CFP. 1932x1916: 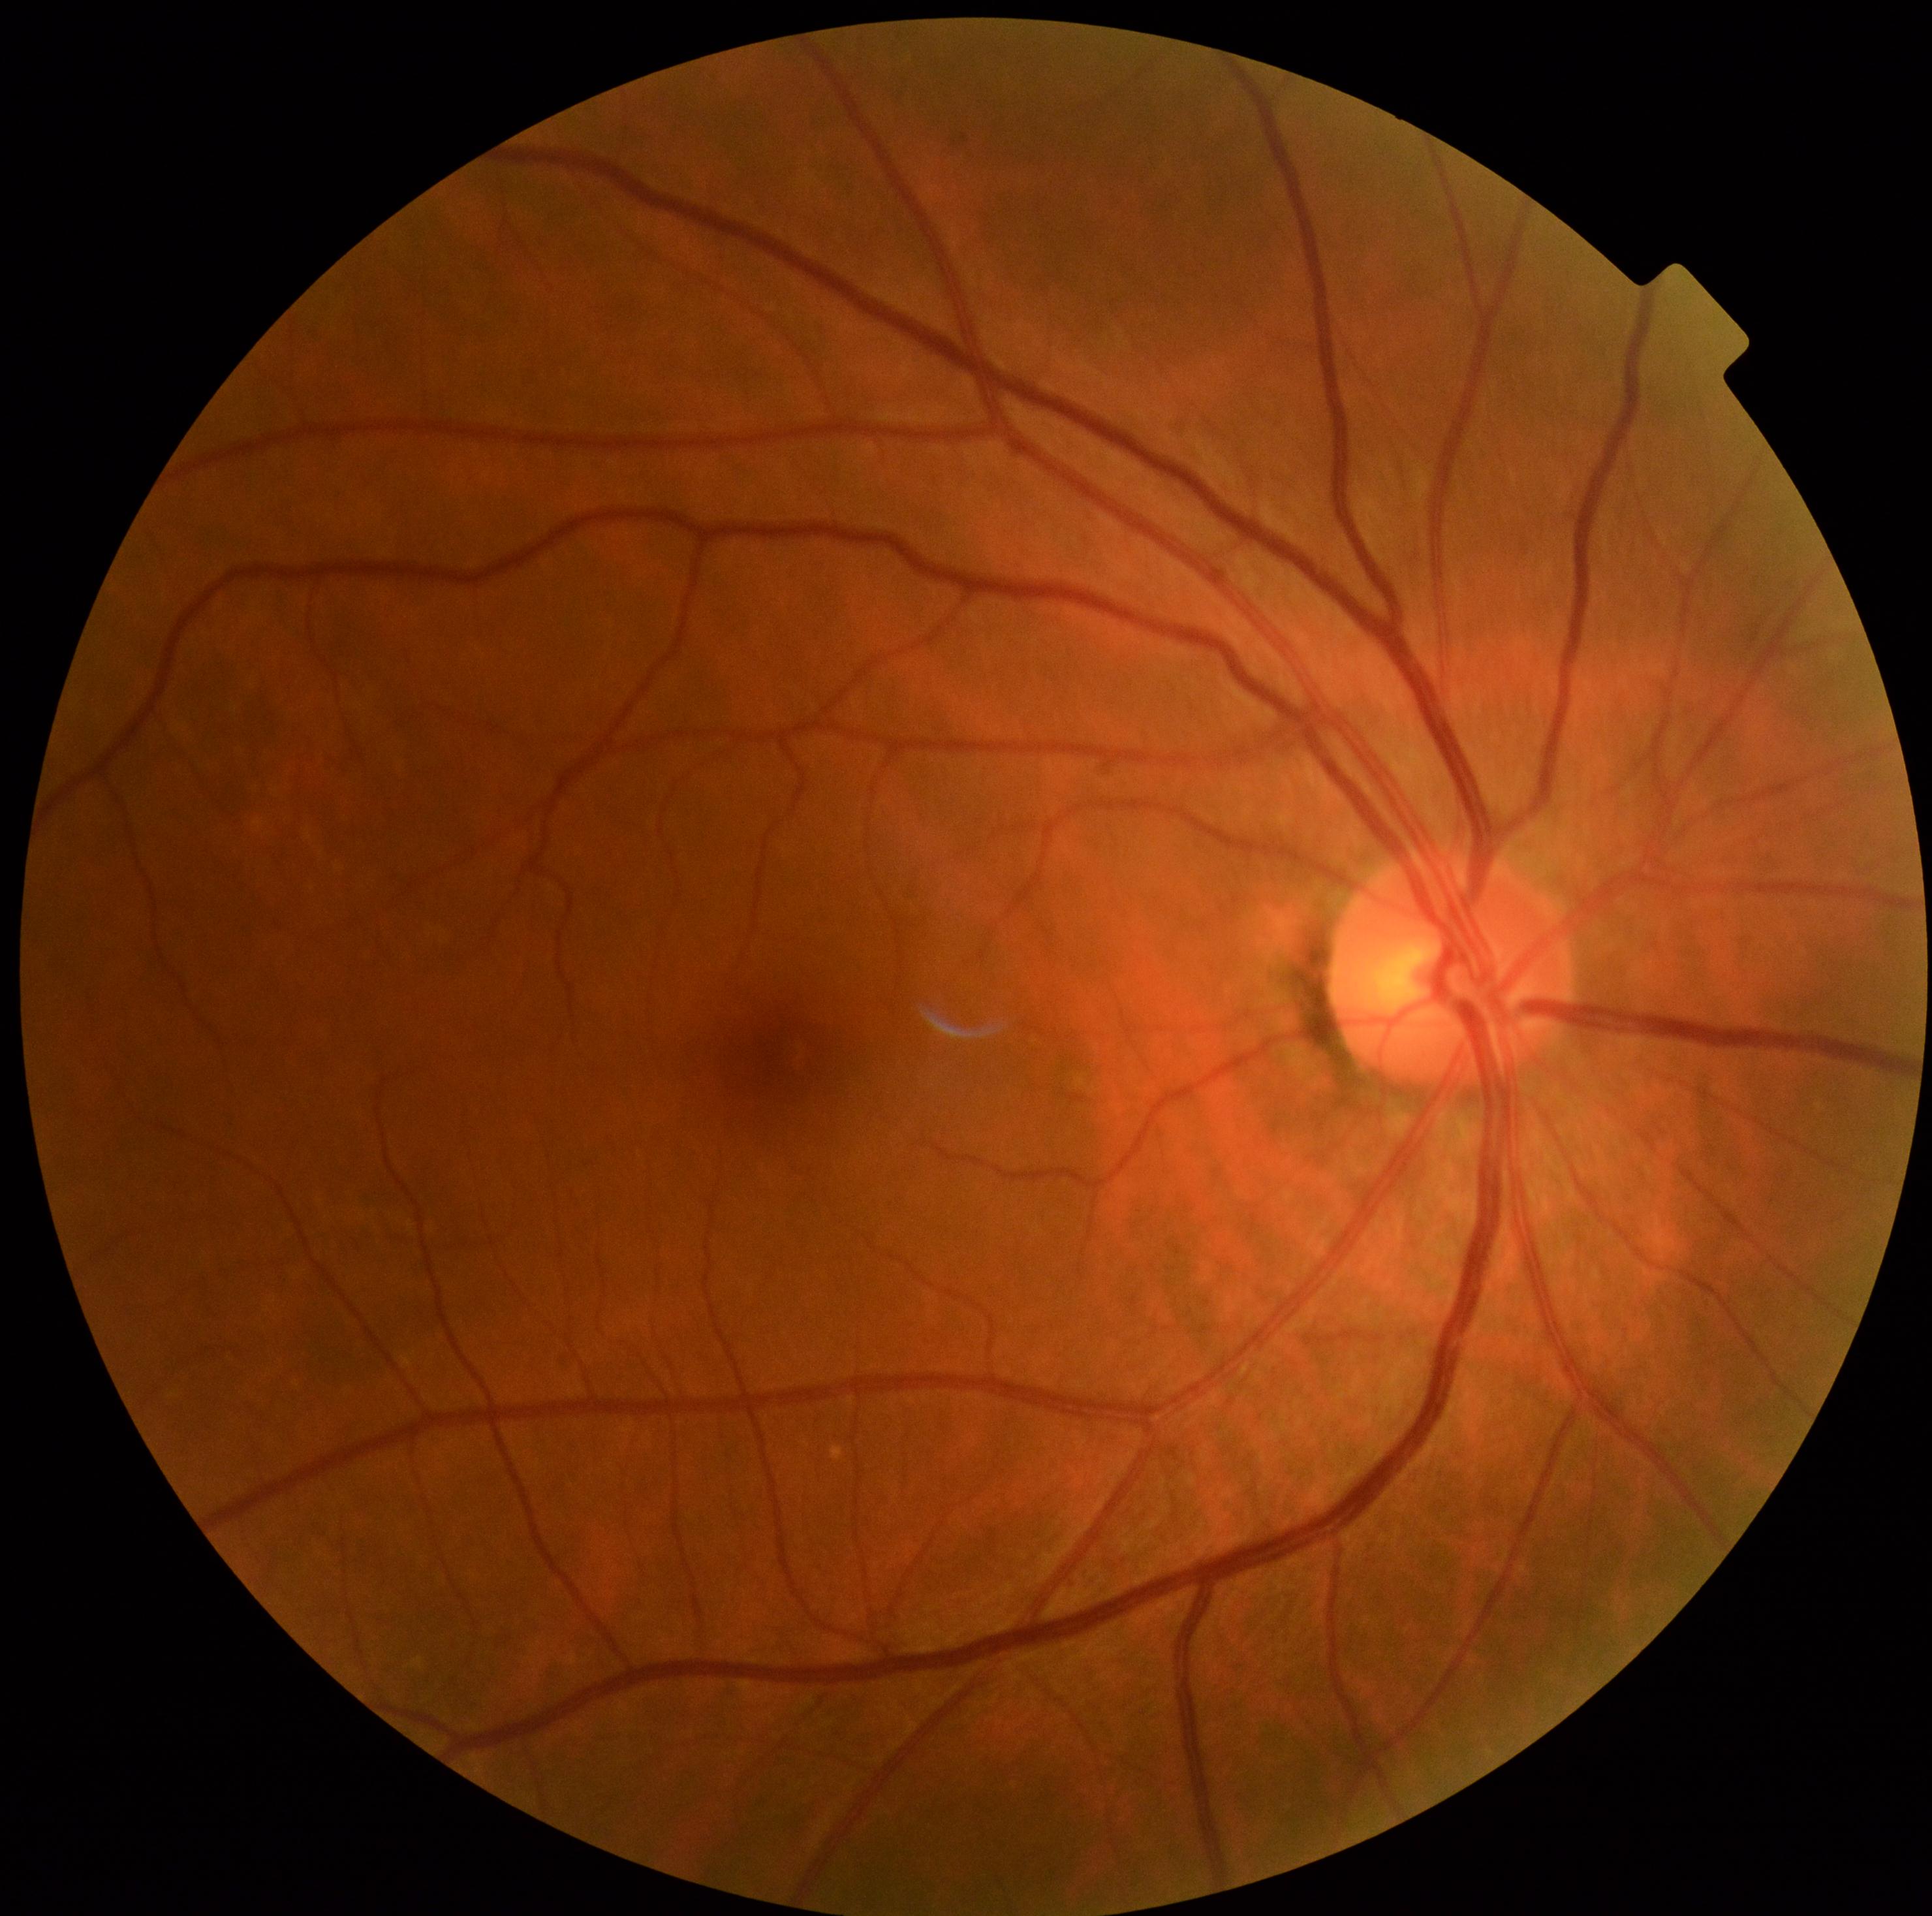

diabetic retinopathy: grade 0 (no apparent retinopathy).